Pediatric wide-field fundus photograph; 130° field of view (Clarity RetCam 3)
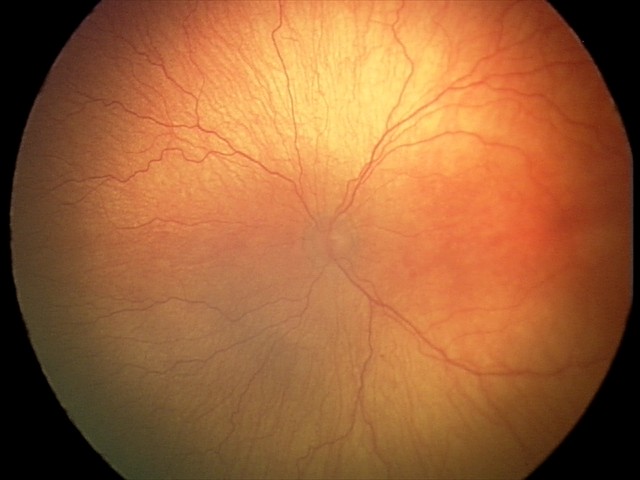

Screening diagnosis: aggressive retinopathy of prematurity — rapidly progressive severe ROP with prominent plus disease, often without classic stage progression.